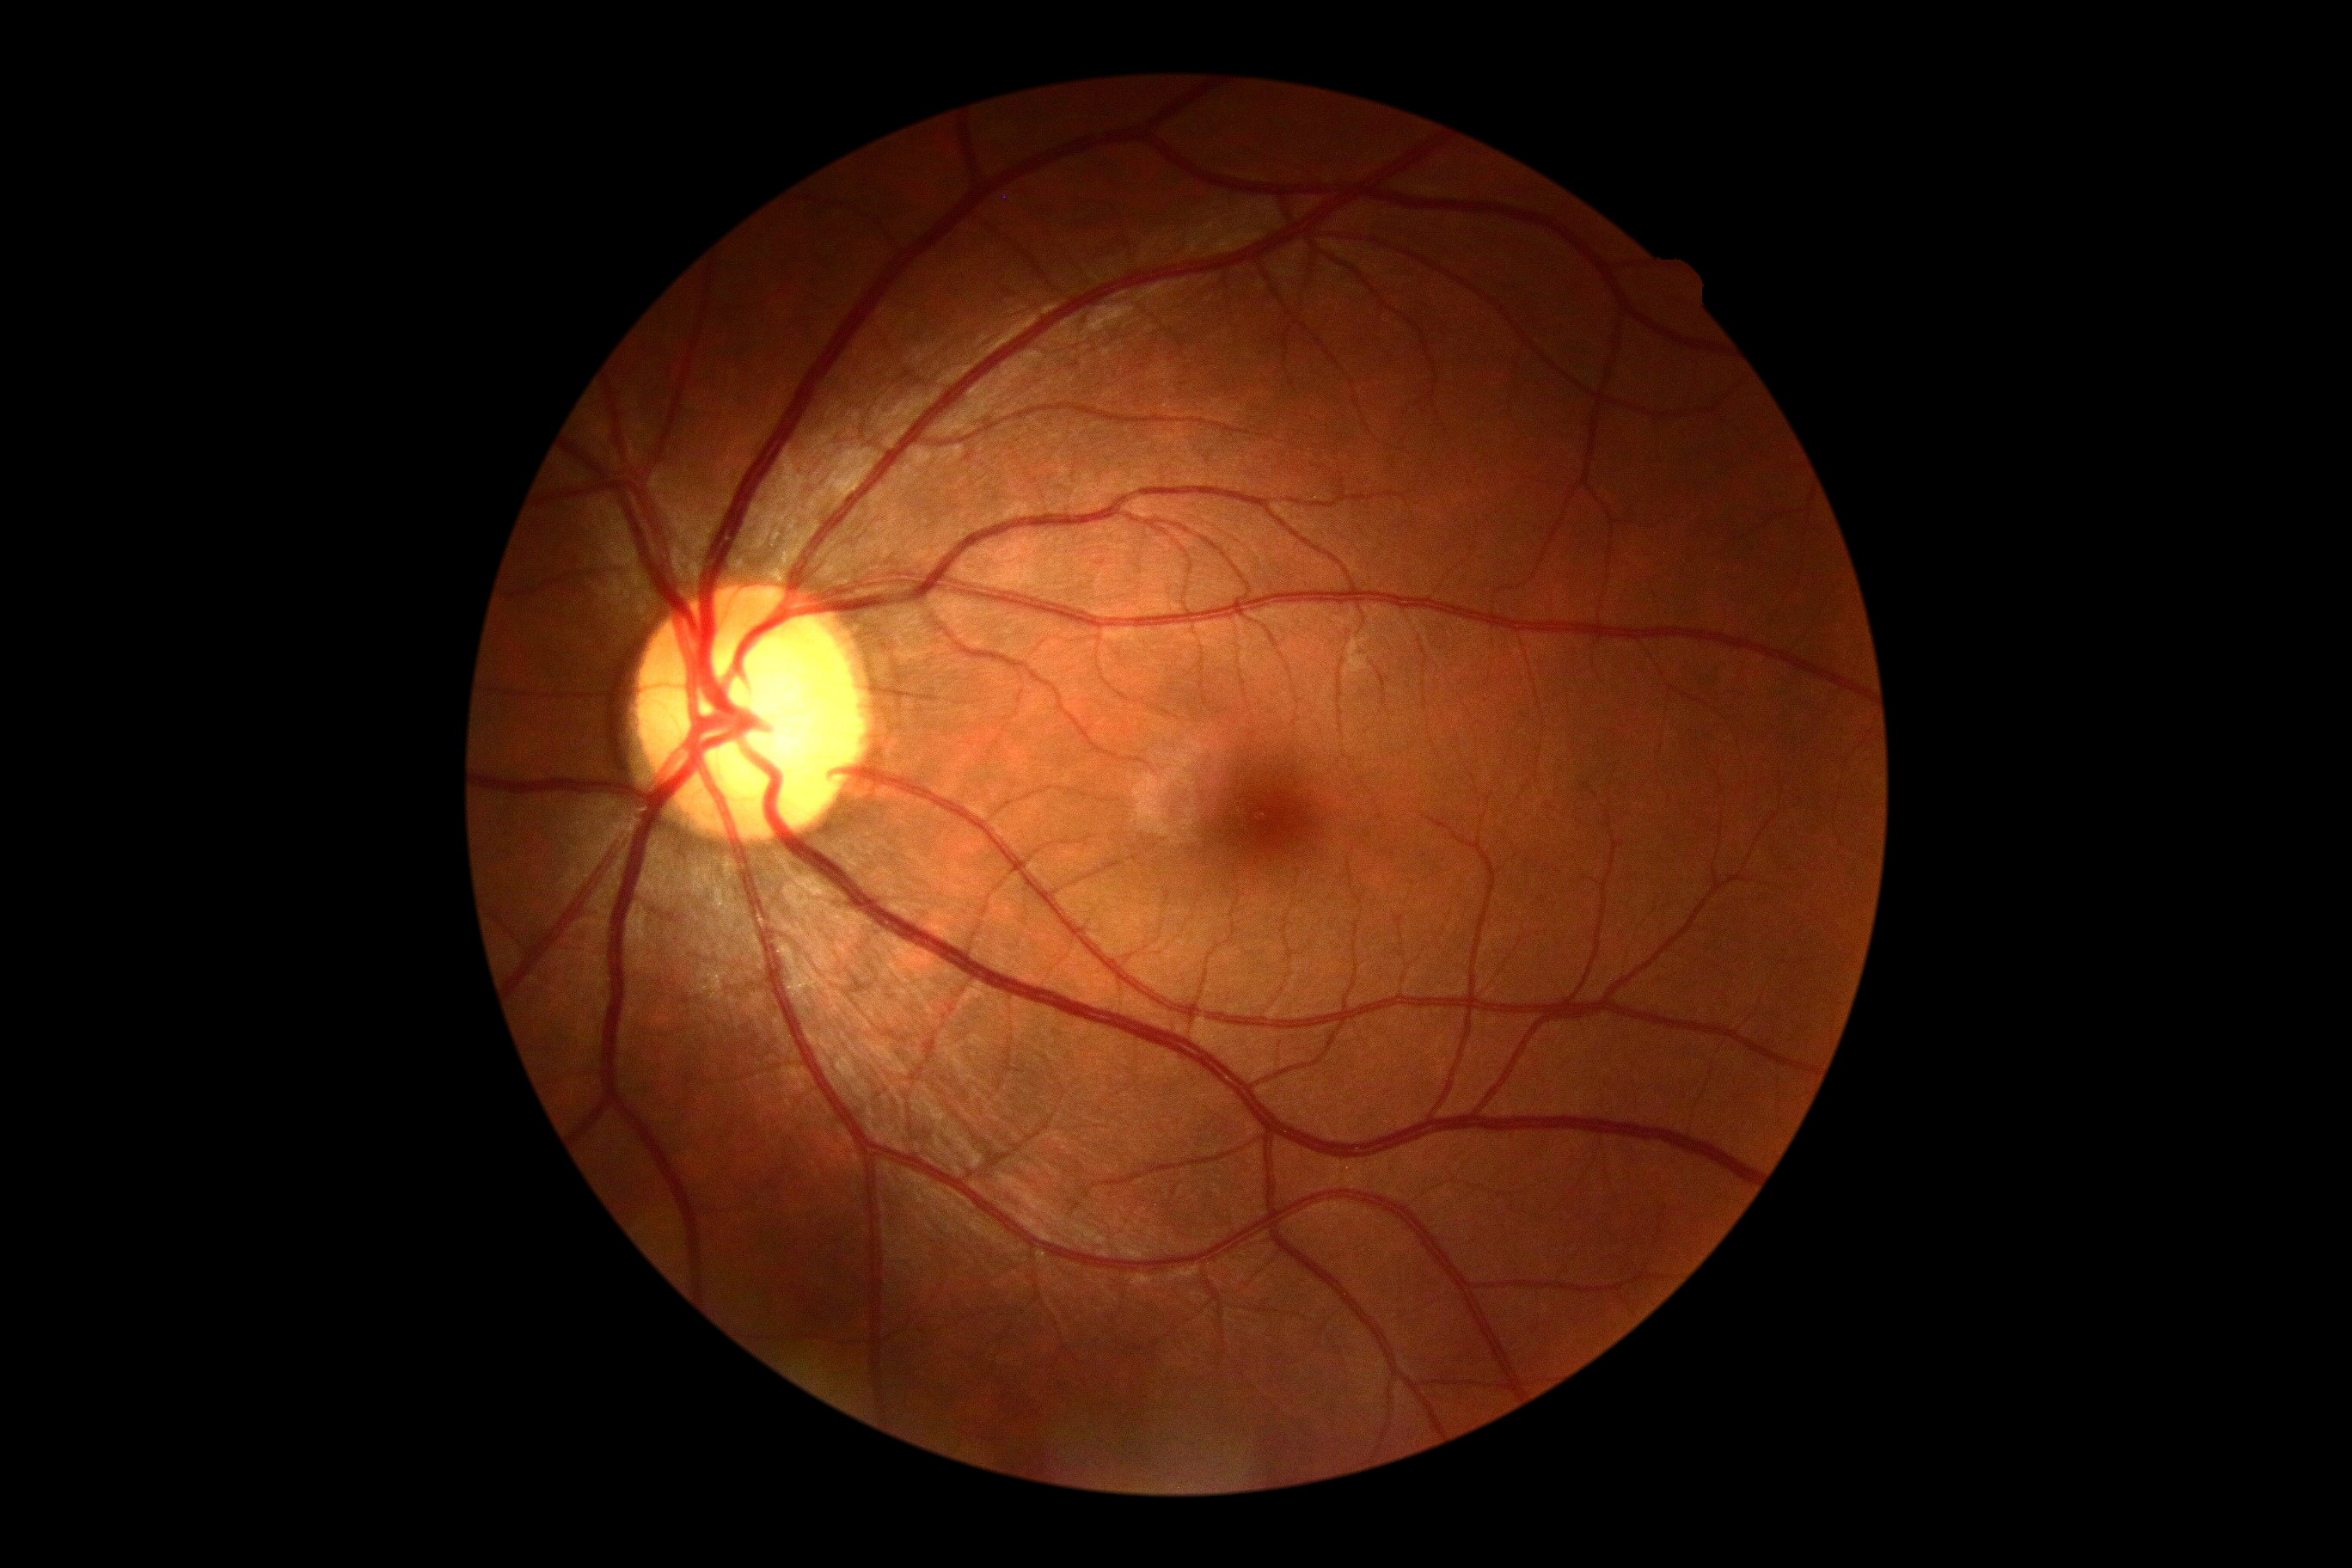 dr_grade: 0/4